45-degree field of view: 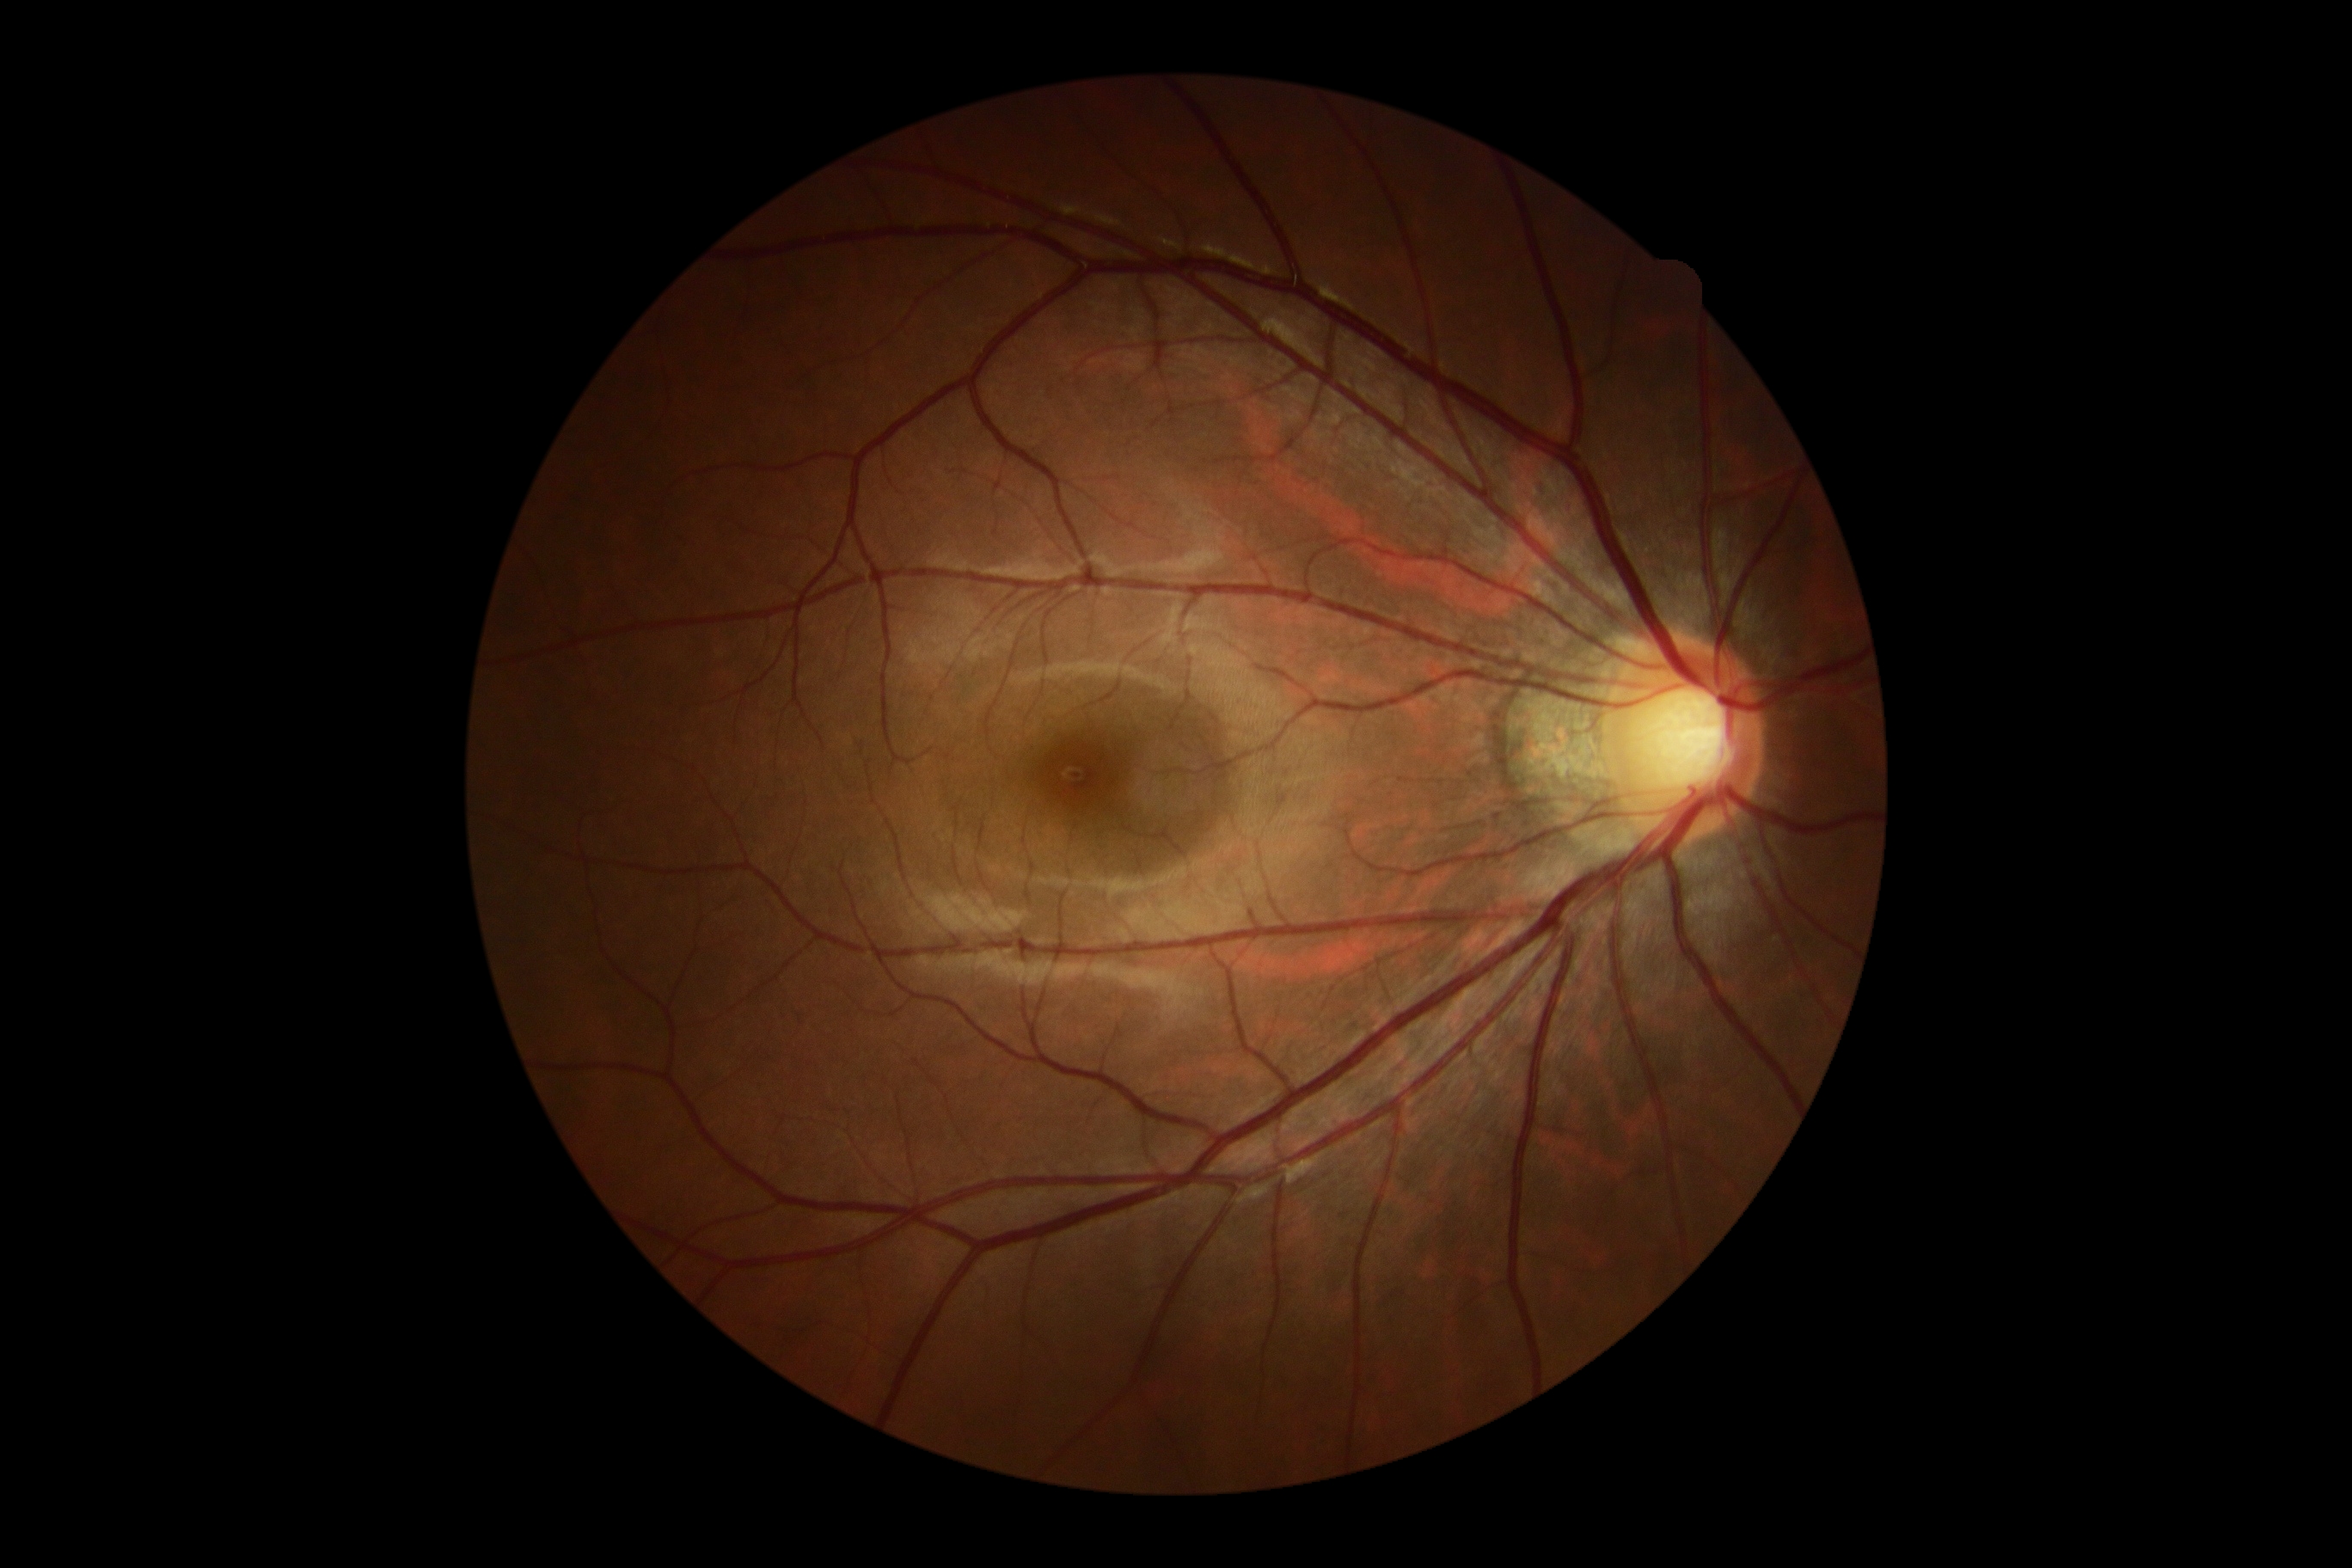

DR stage: no apparent diabetic retinopathy (grade 0) — no visible signs of diabetic retinopathy.
No apparent diabetic retinopathy.